Color fundus image
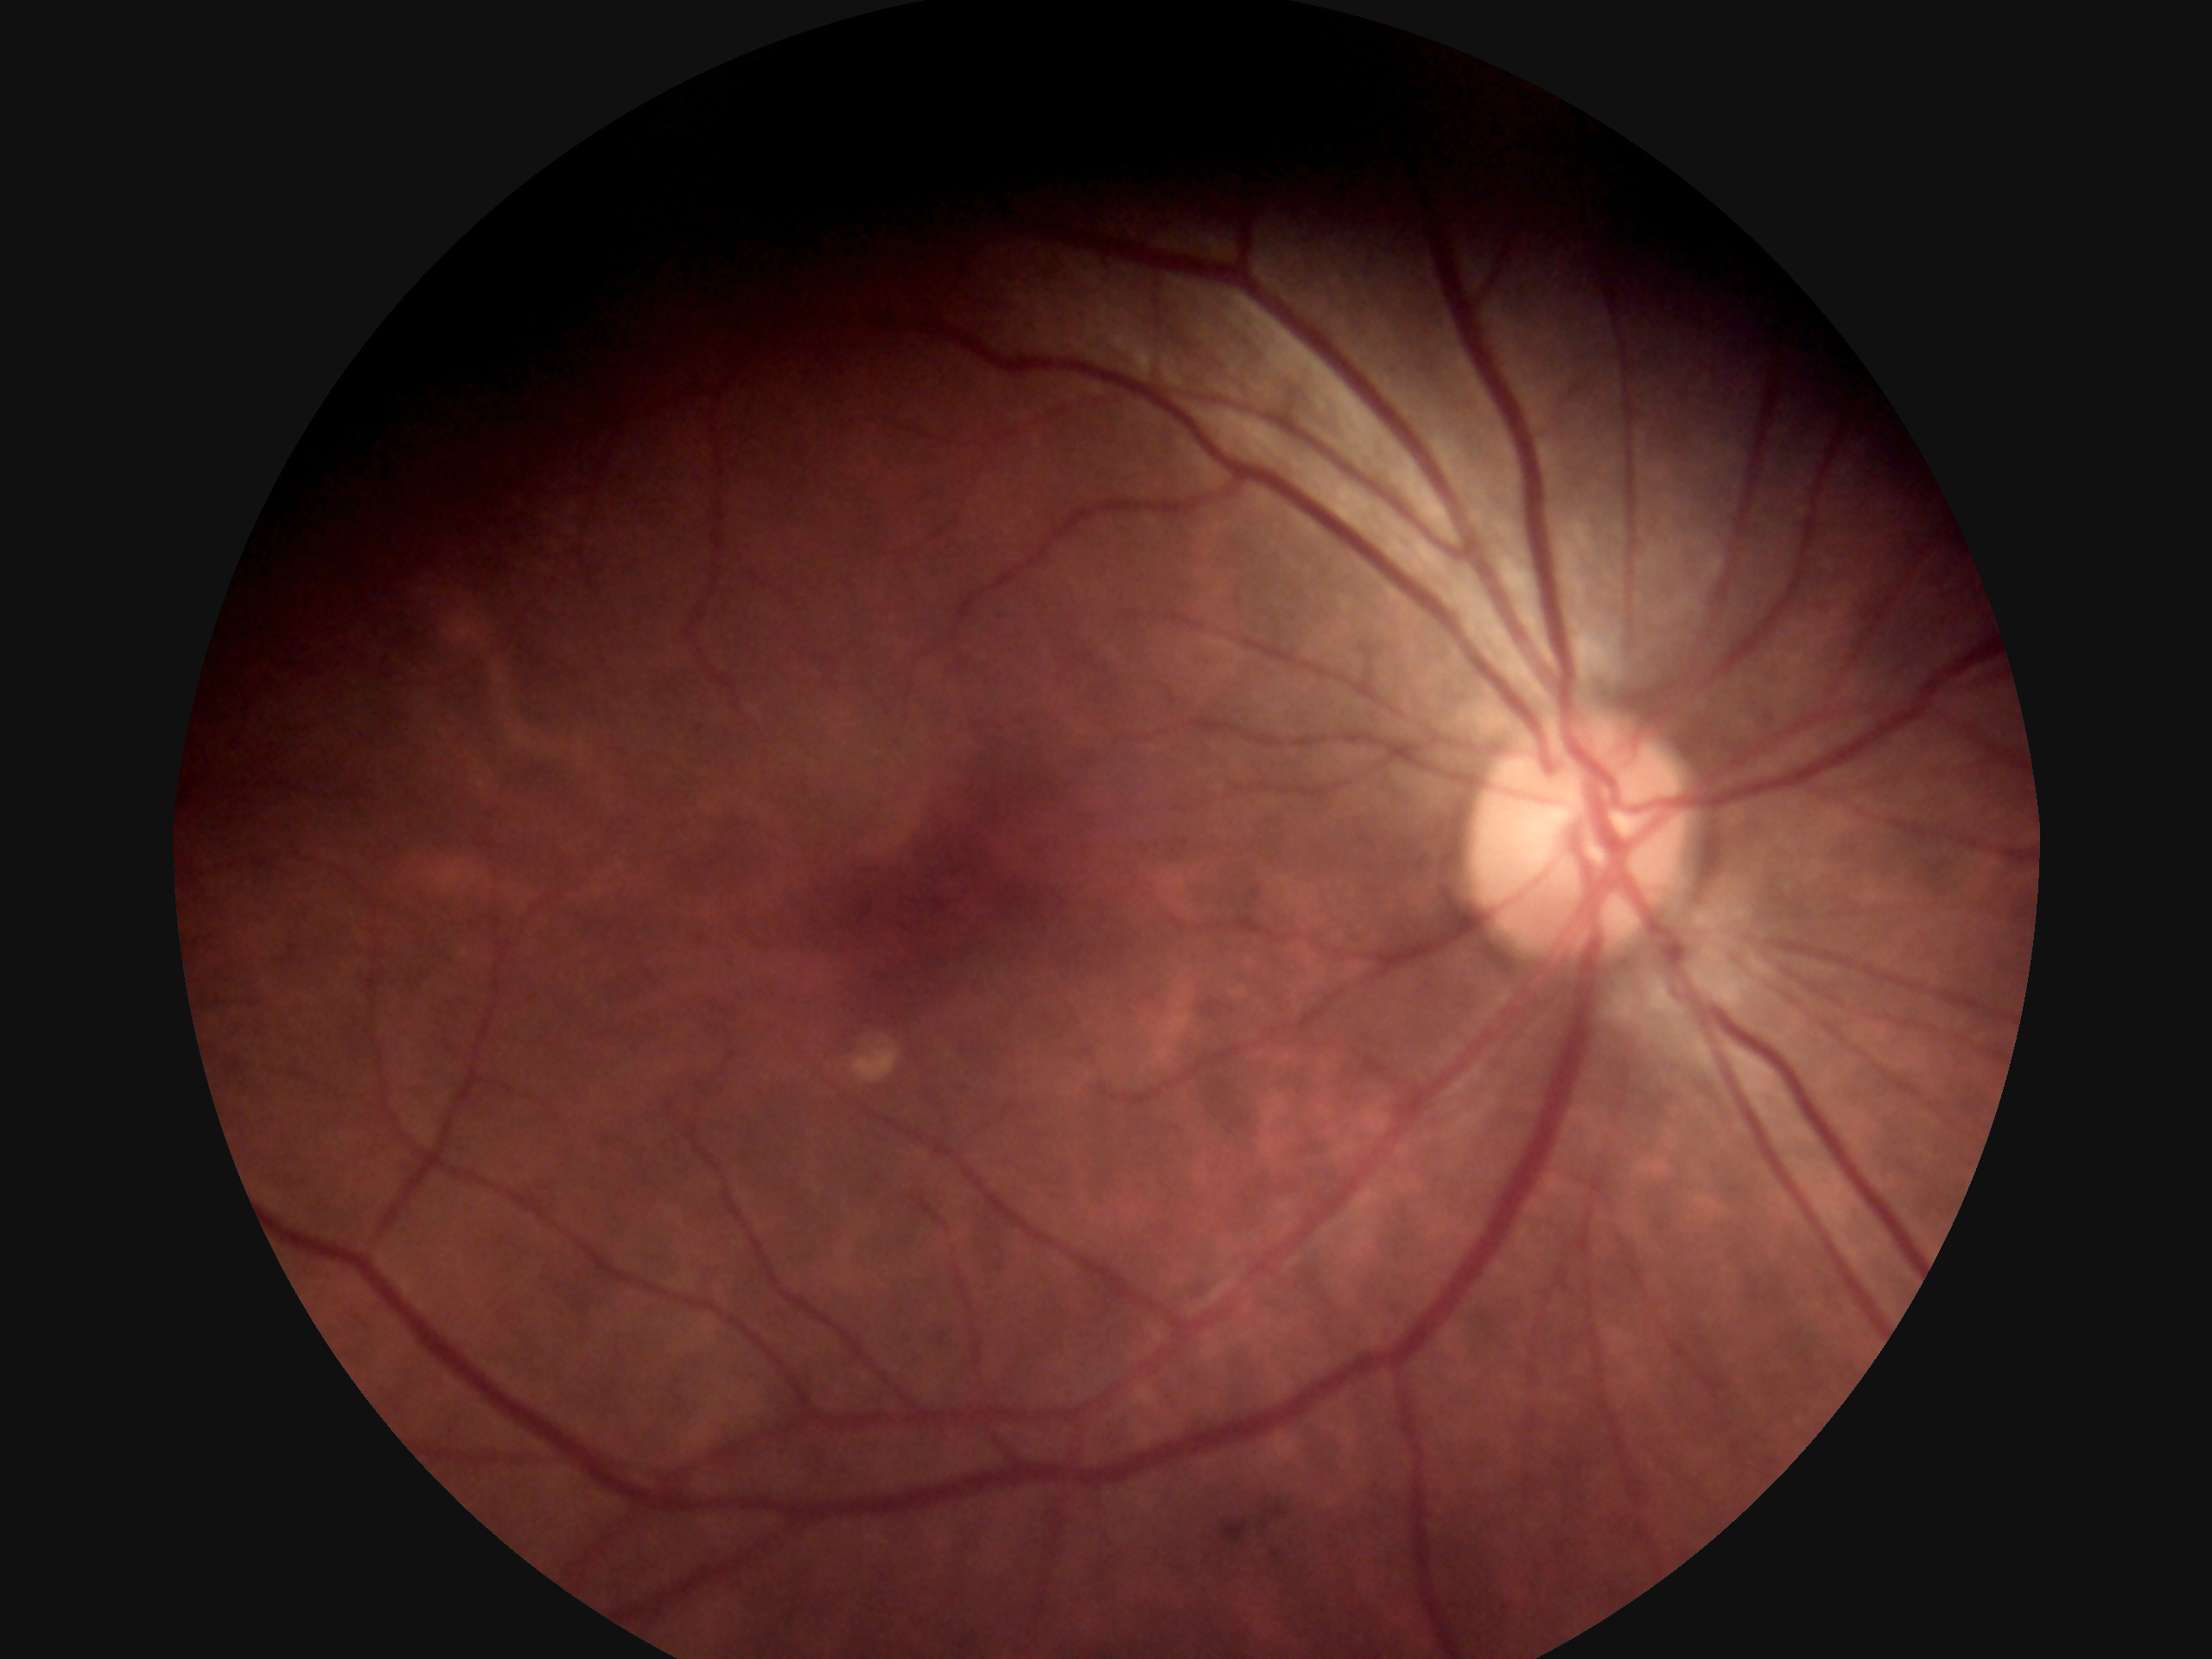
No signs of diabetic retinopathy.
DR is grade 0 (no apparent retinopathy).